848 by 848 pixels — 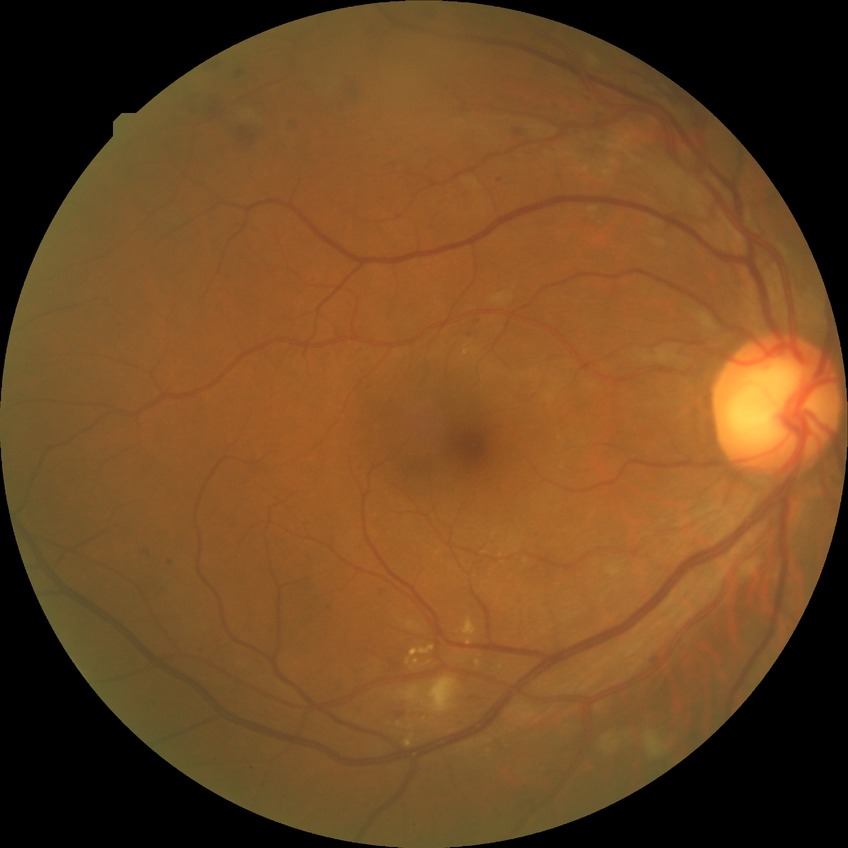

DR class = non-proliferative diabetic retinopathy
diabetic retinopathy (DR) = pre-proliferative diabetic retinopathy (PPDR)